Fundus photo · camera: Remidio Fundus on Phone.
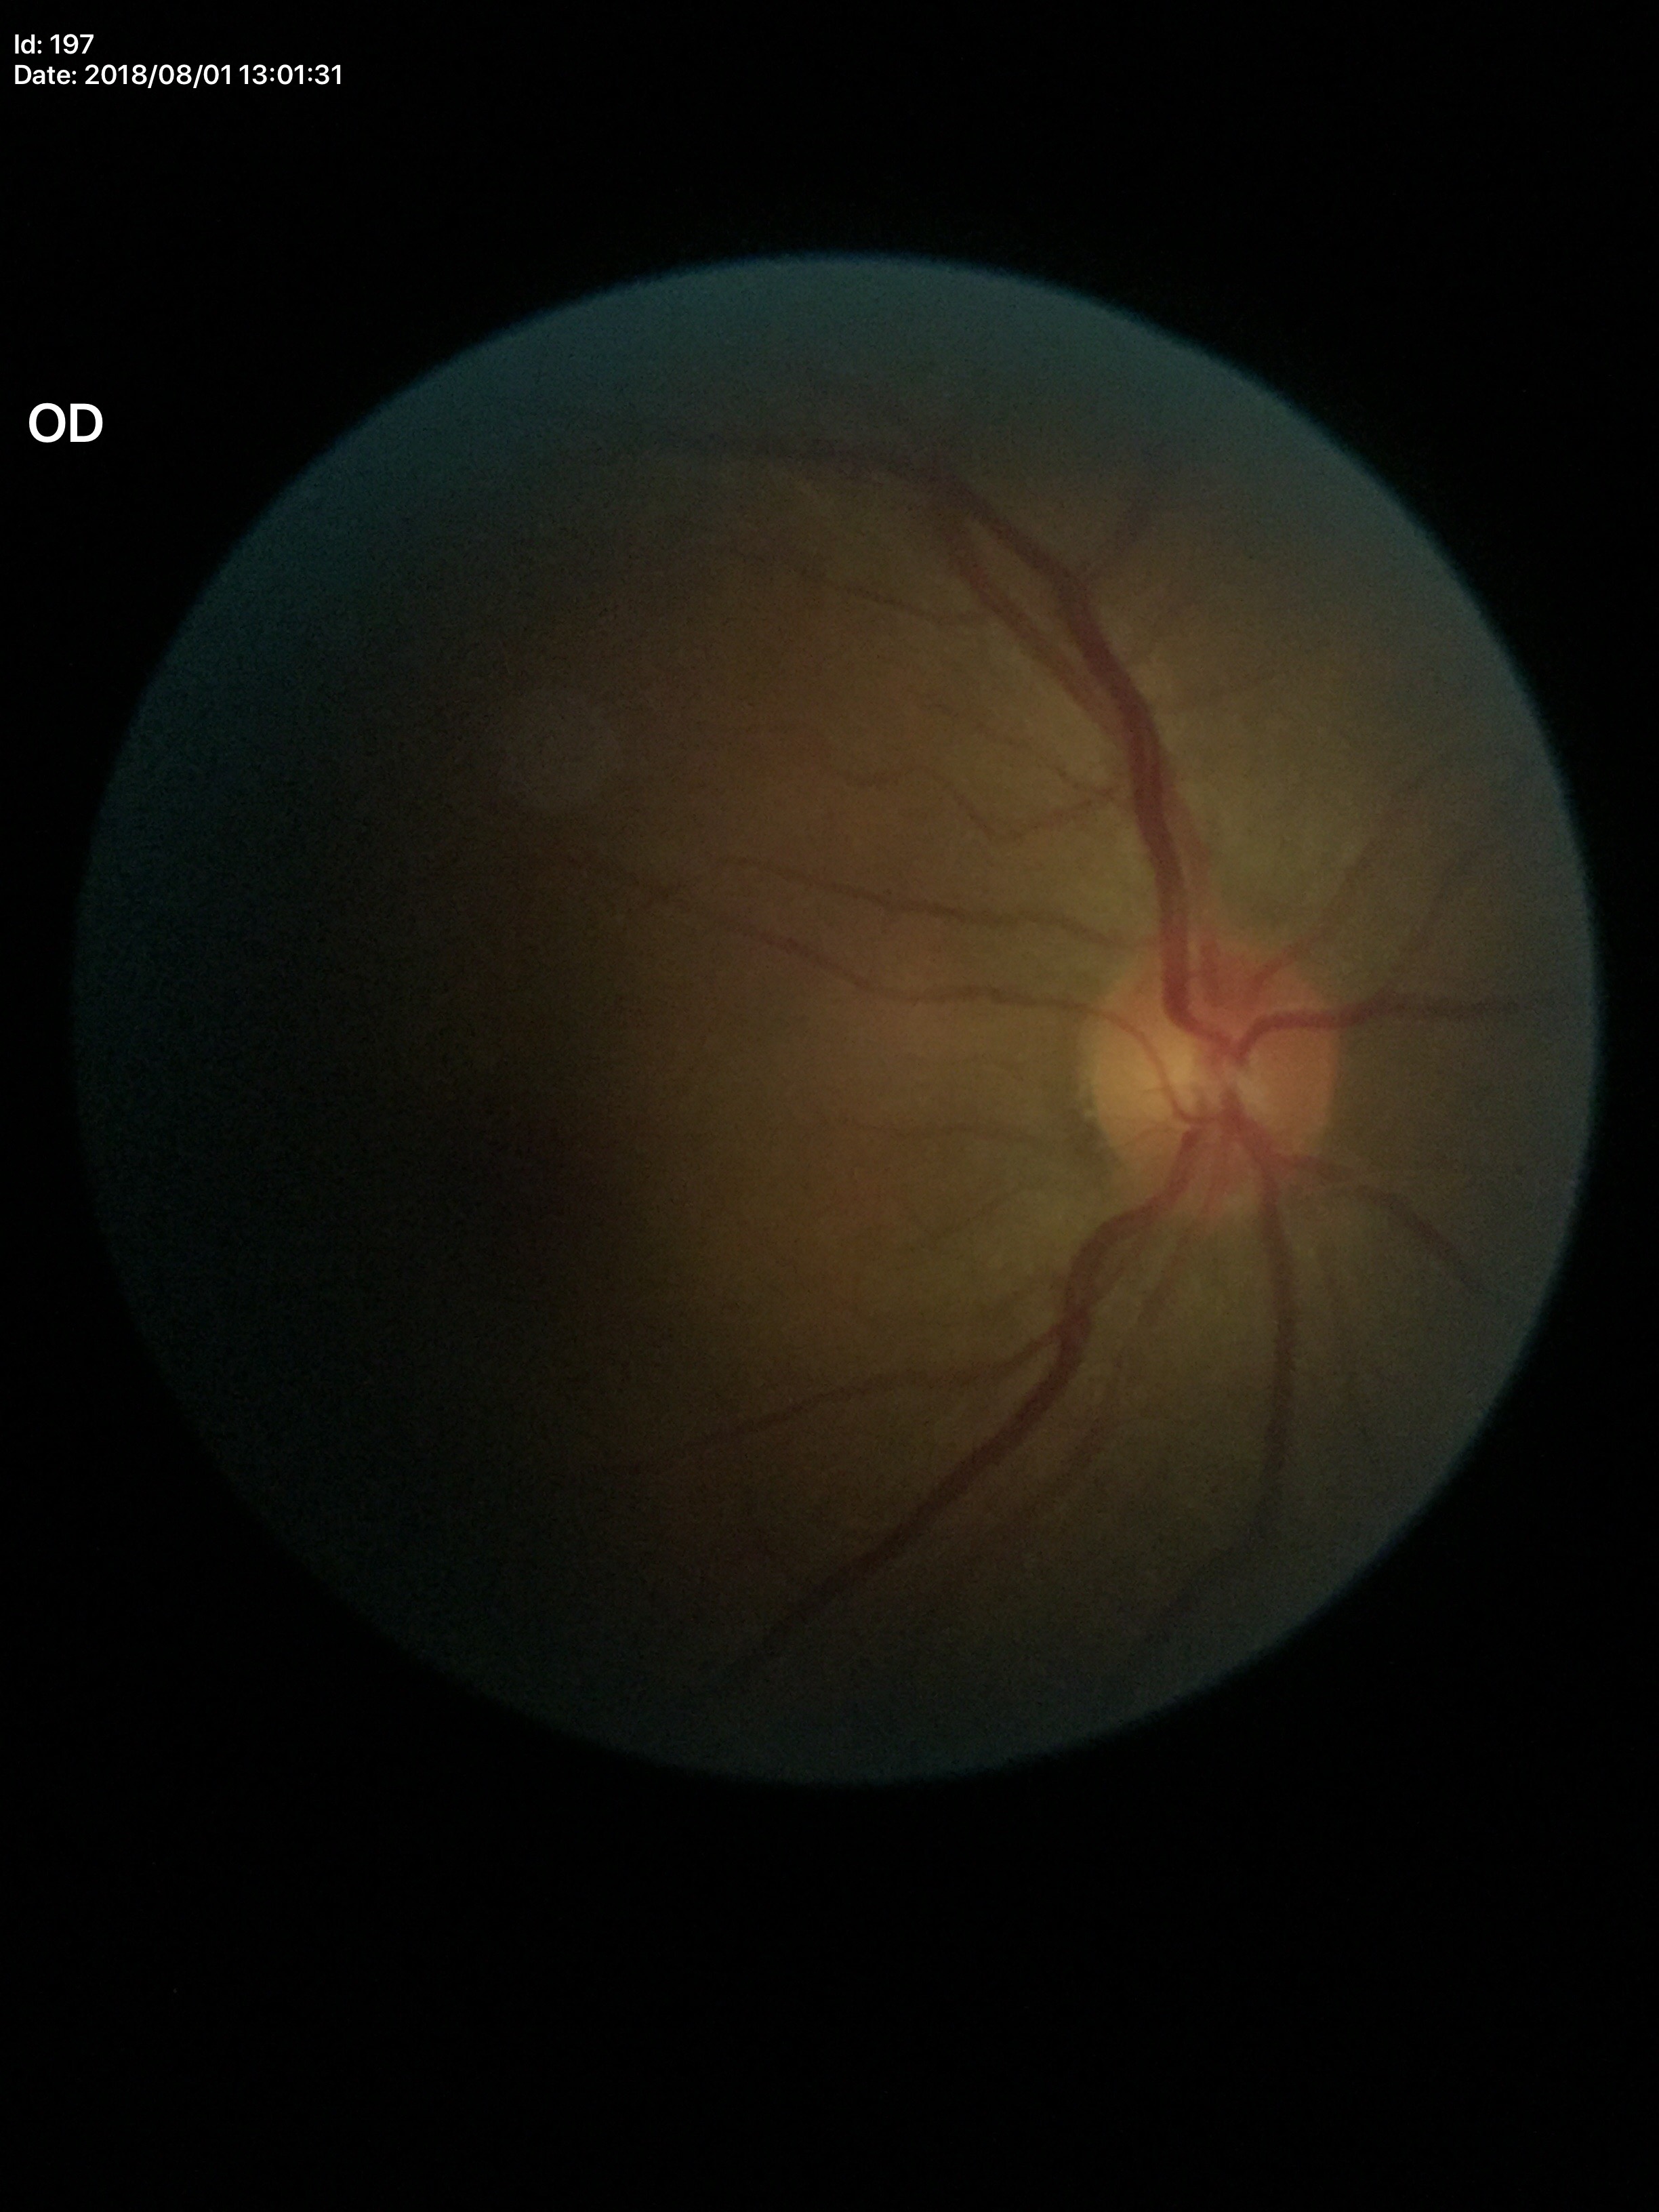
Negative for glaucoma suspicion.
Vertical cup-disc ratio (VCDR): 0.50.